Image size 2212x1659
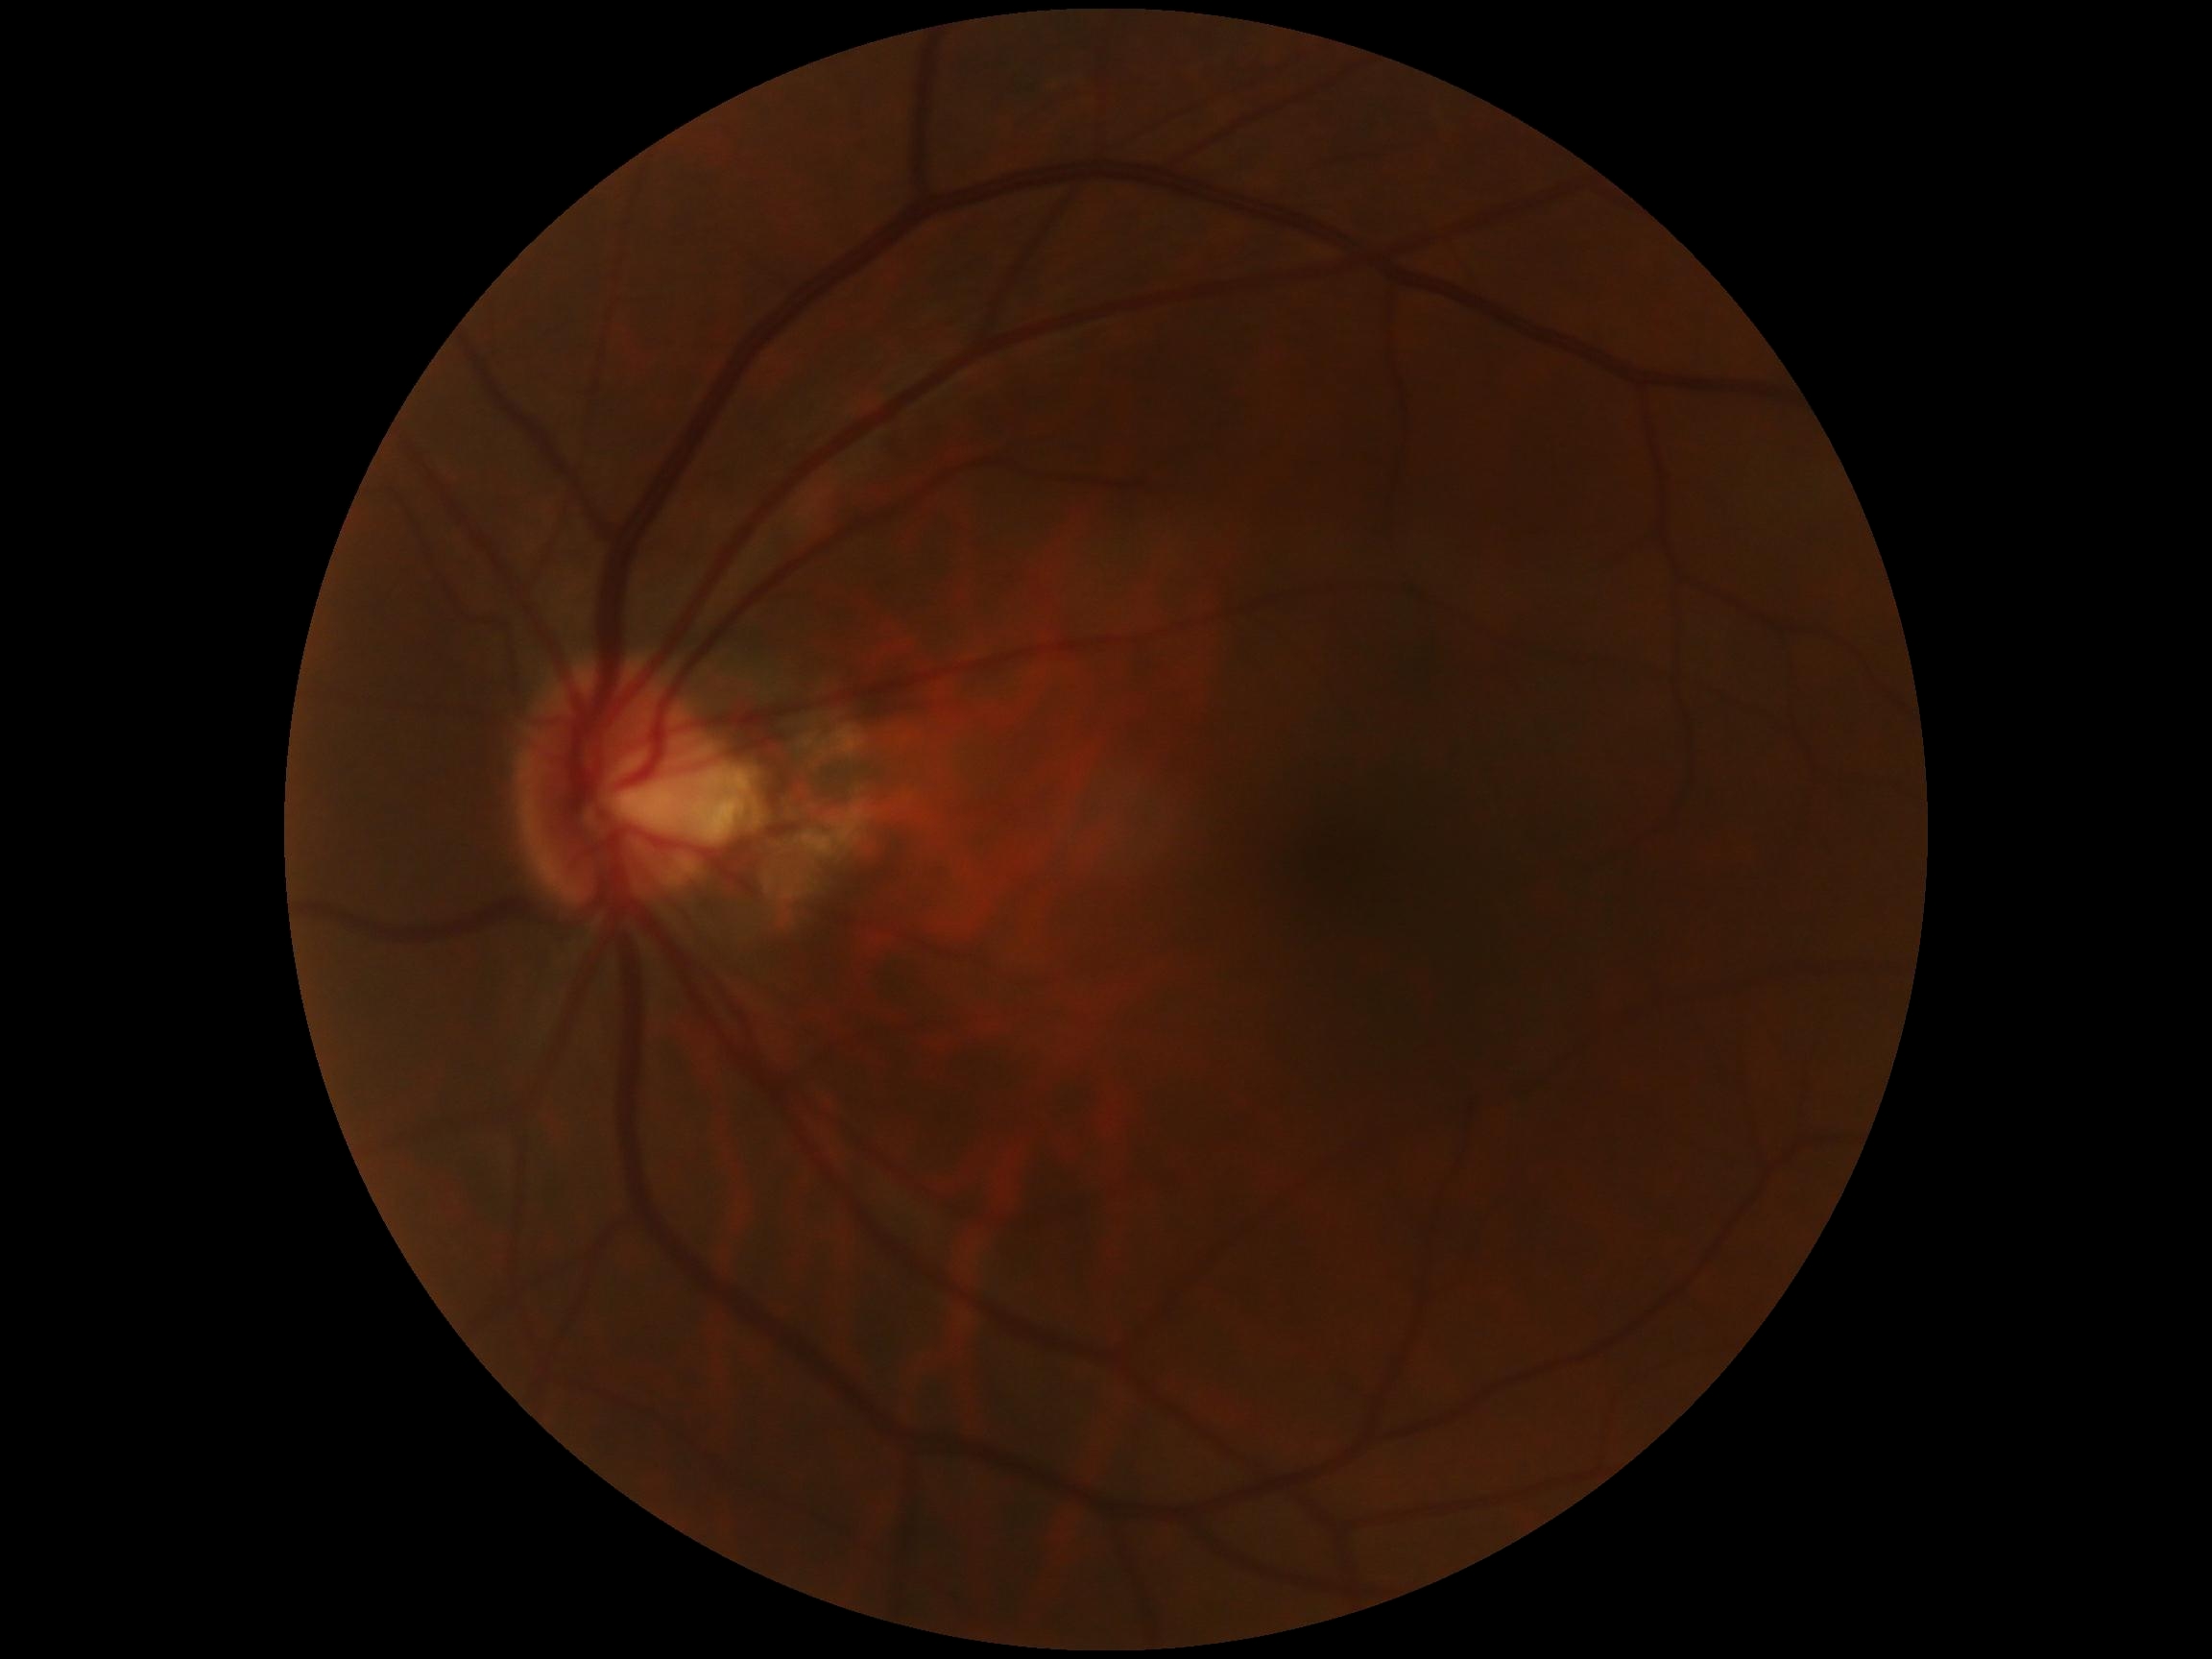
DR: no apparent retinopathy (grade 0) — no visible signs of diabetic retinopathy.